45° FOV:
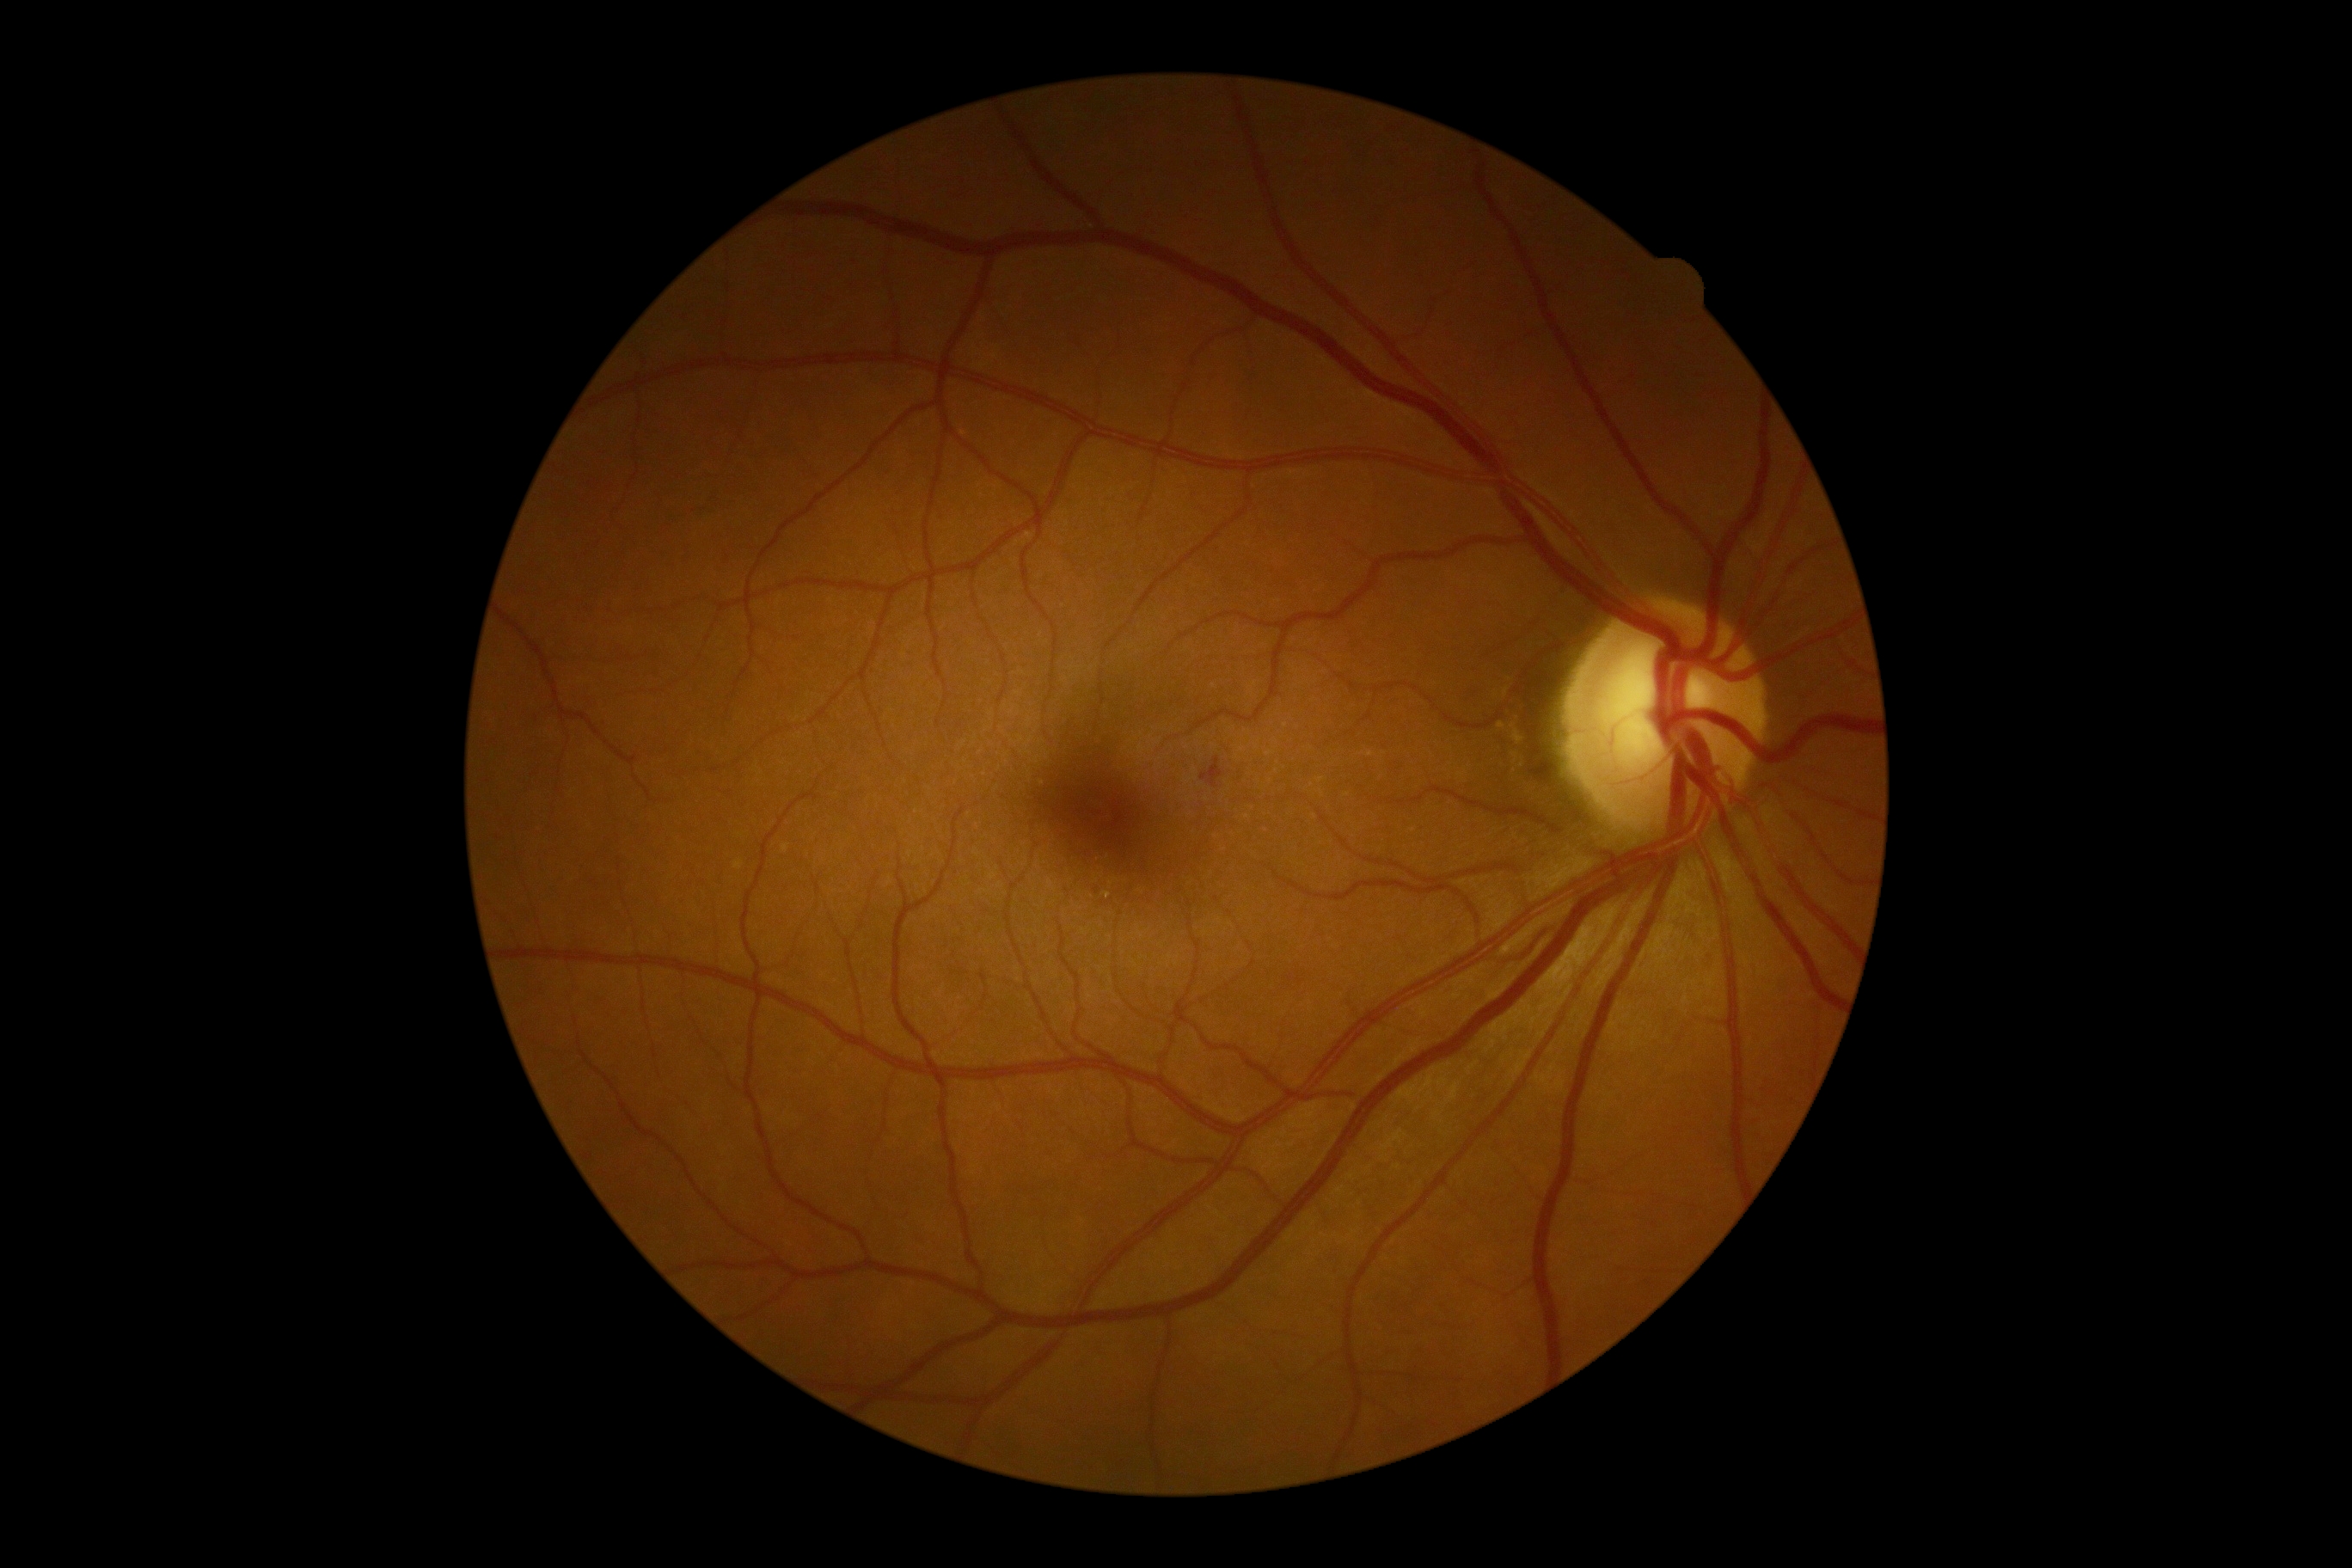
DR stage is 2/4.